2212 x 1659 pixels — 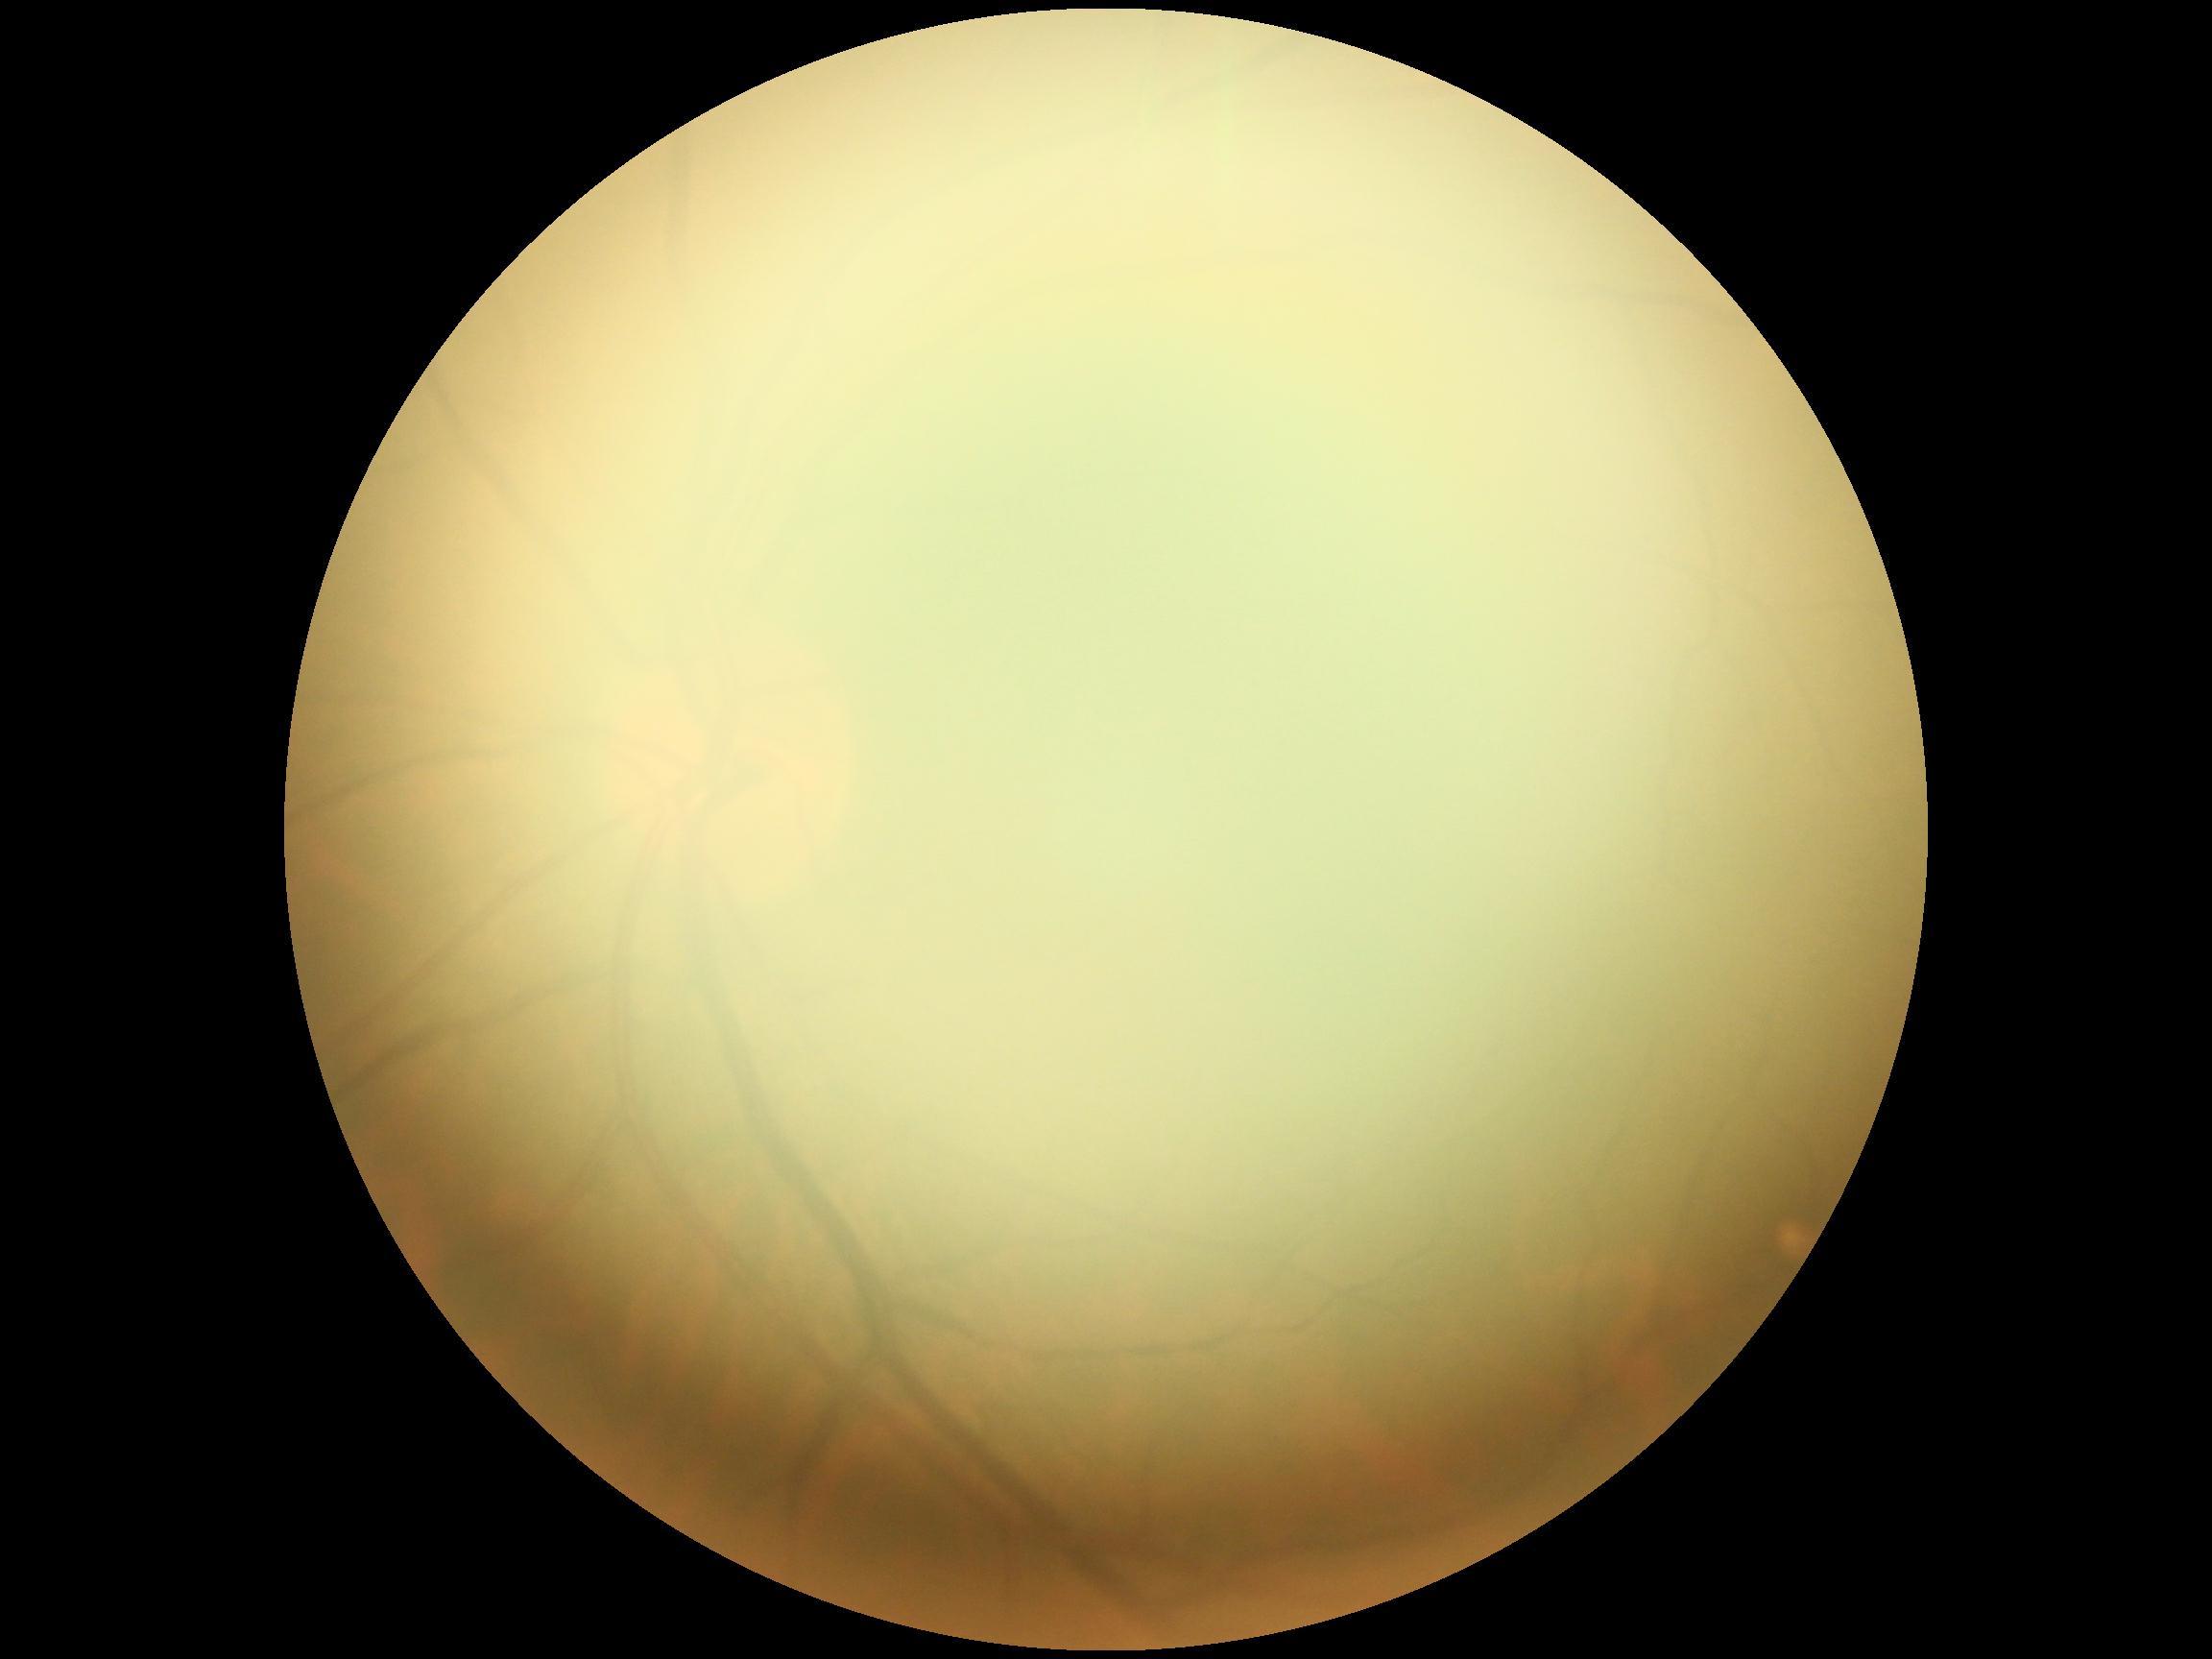 * diabetic retinopathy (DR): ungradable